45° field of view; nonmydriatic — 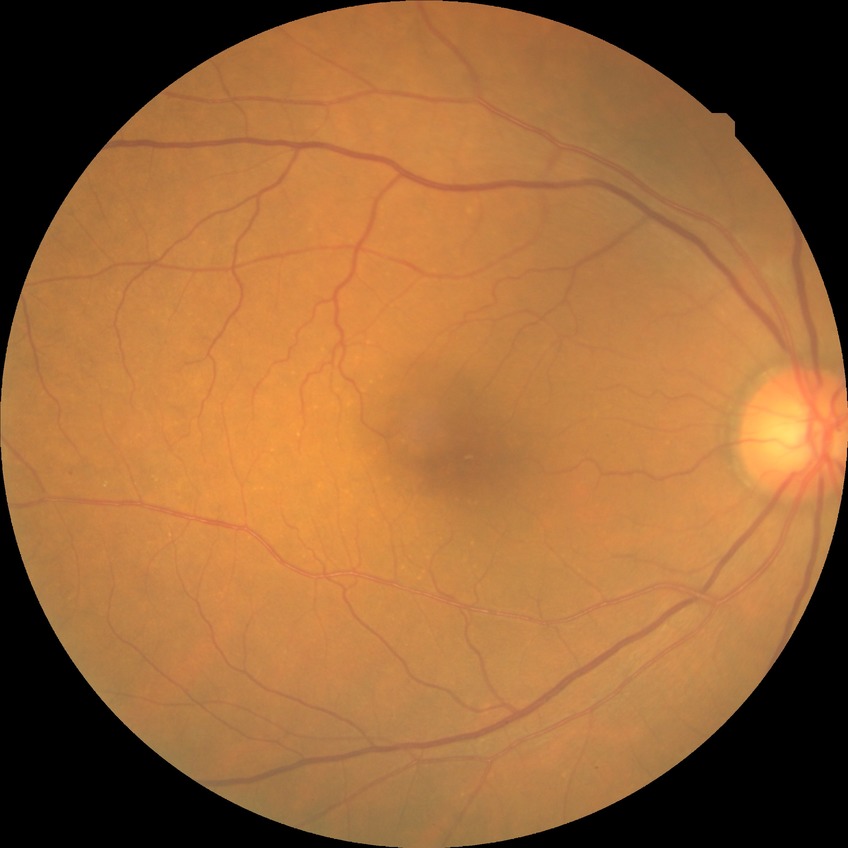 Diabetic retinopathy (DR) is SDR (simple diabetic retinopathy).
The retinopathy is classified as non-proliferative diabetic retinopathy.